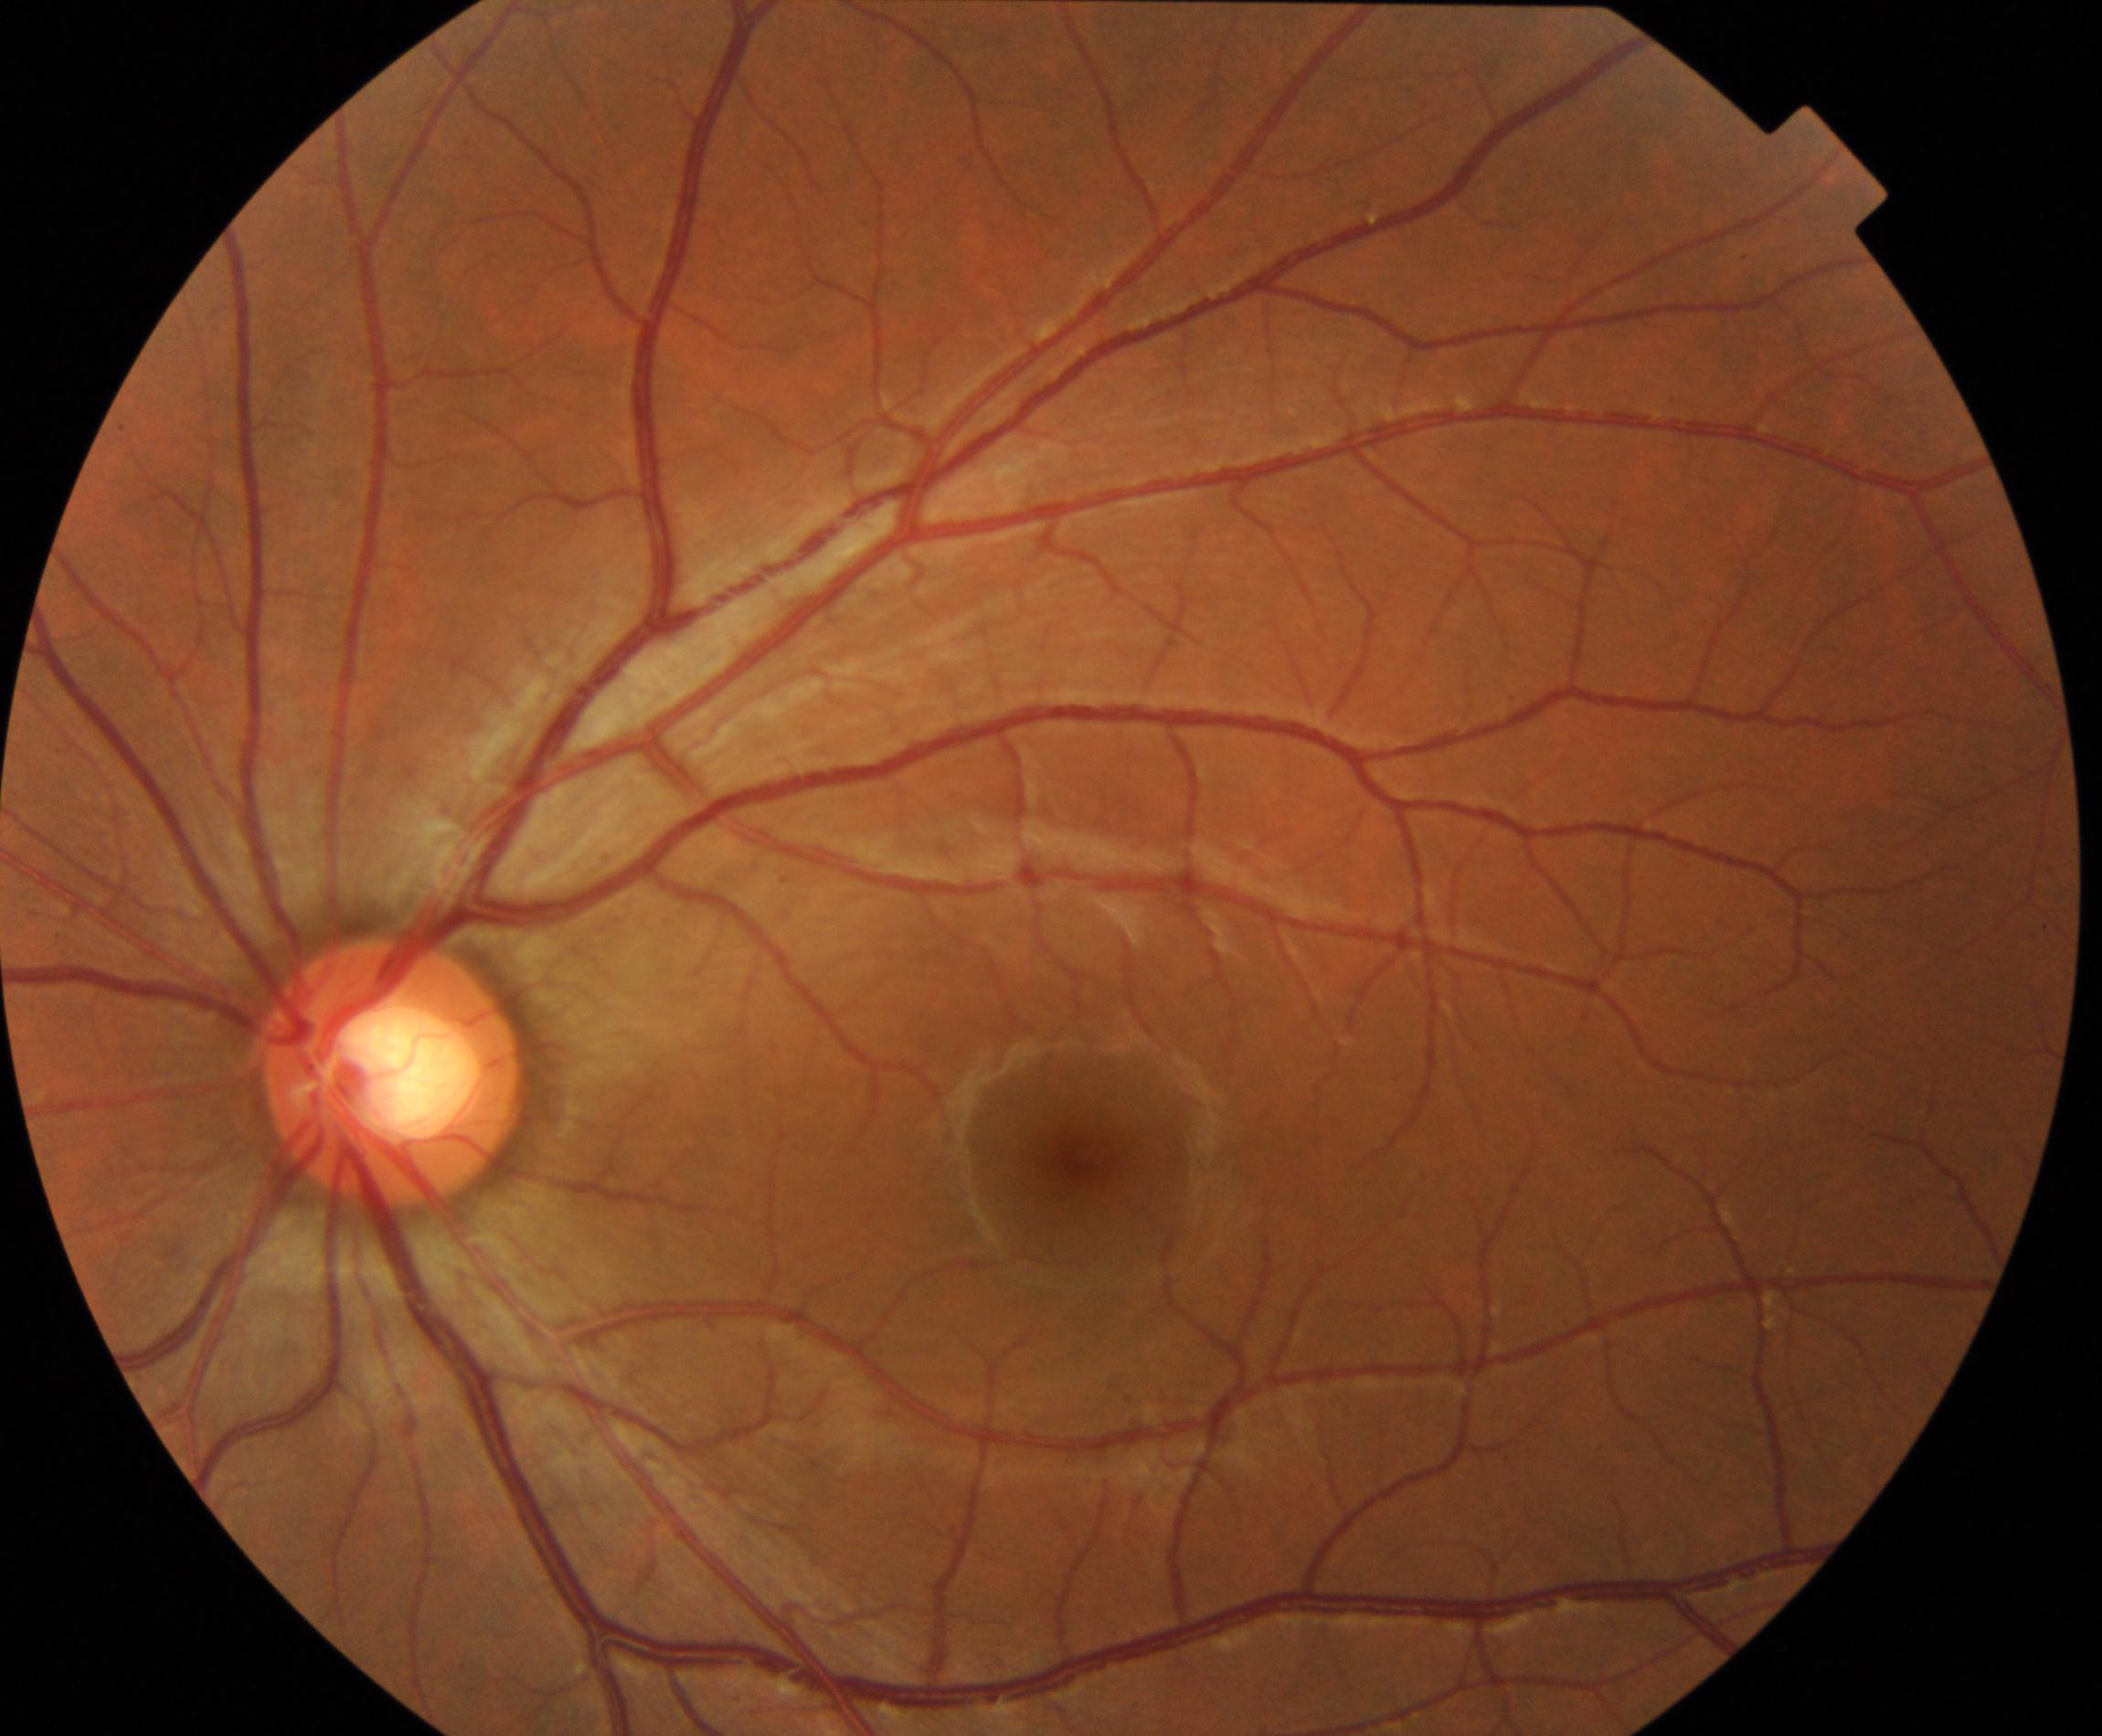
There is evidence of large optic cup.